2352 x 1568 pixels · 45° FOV · color fundus photograph: 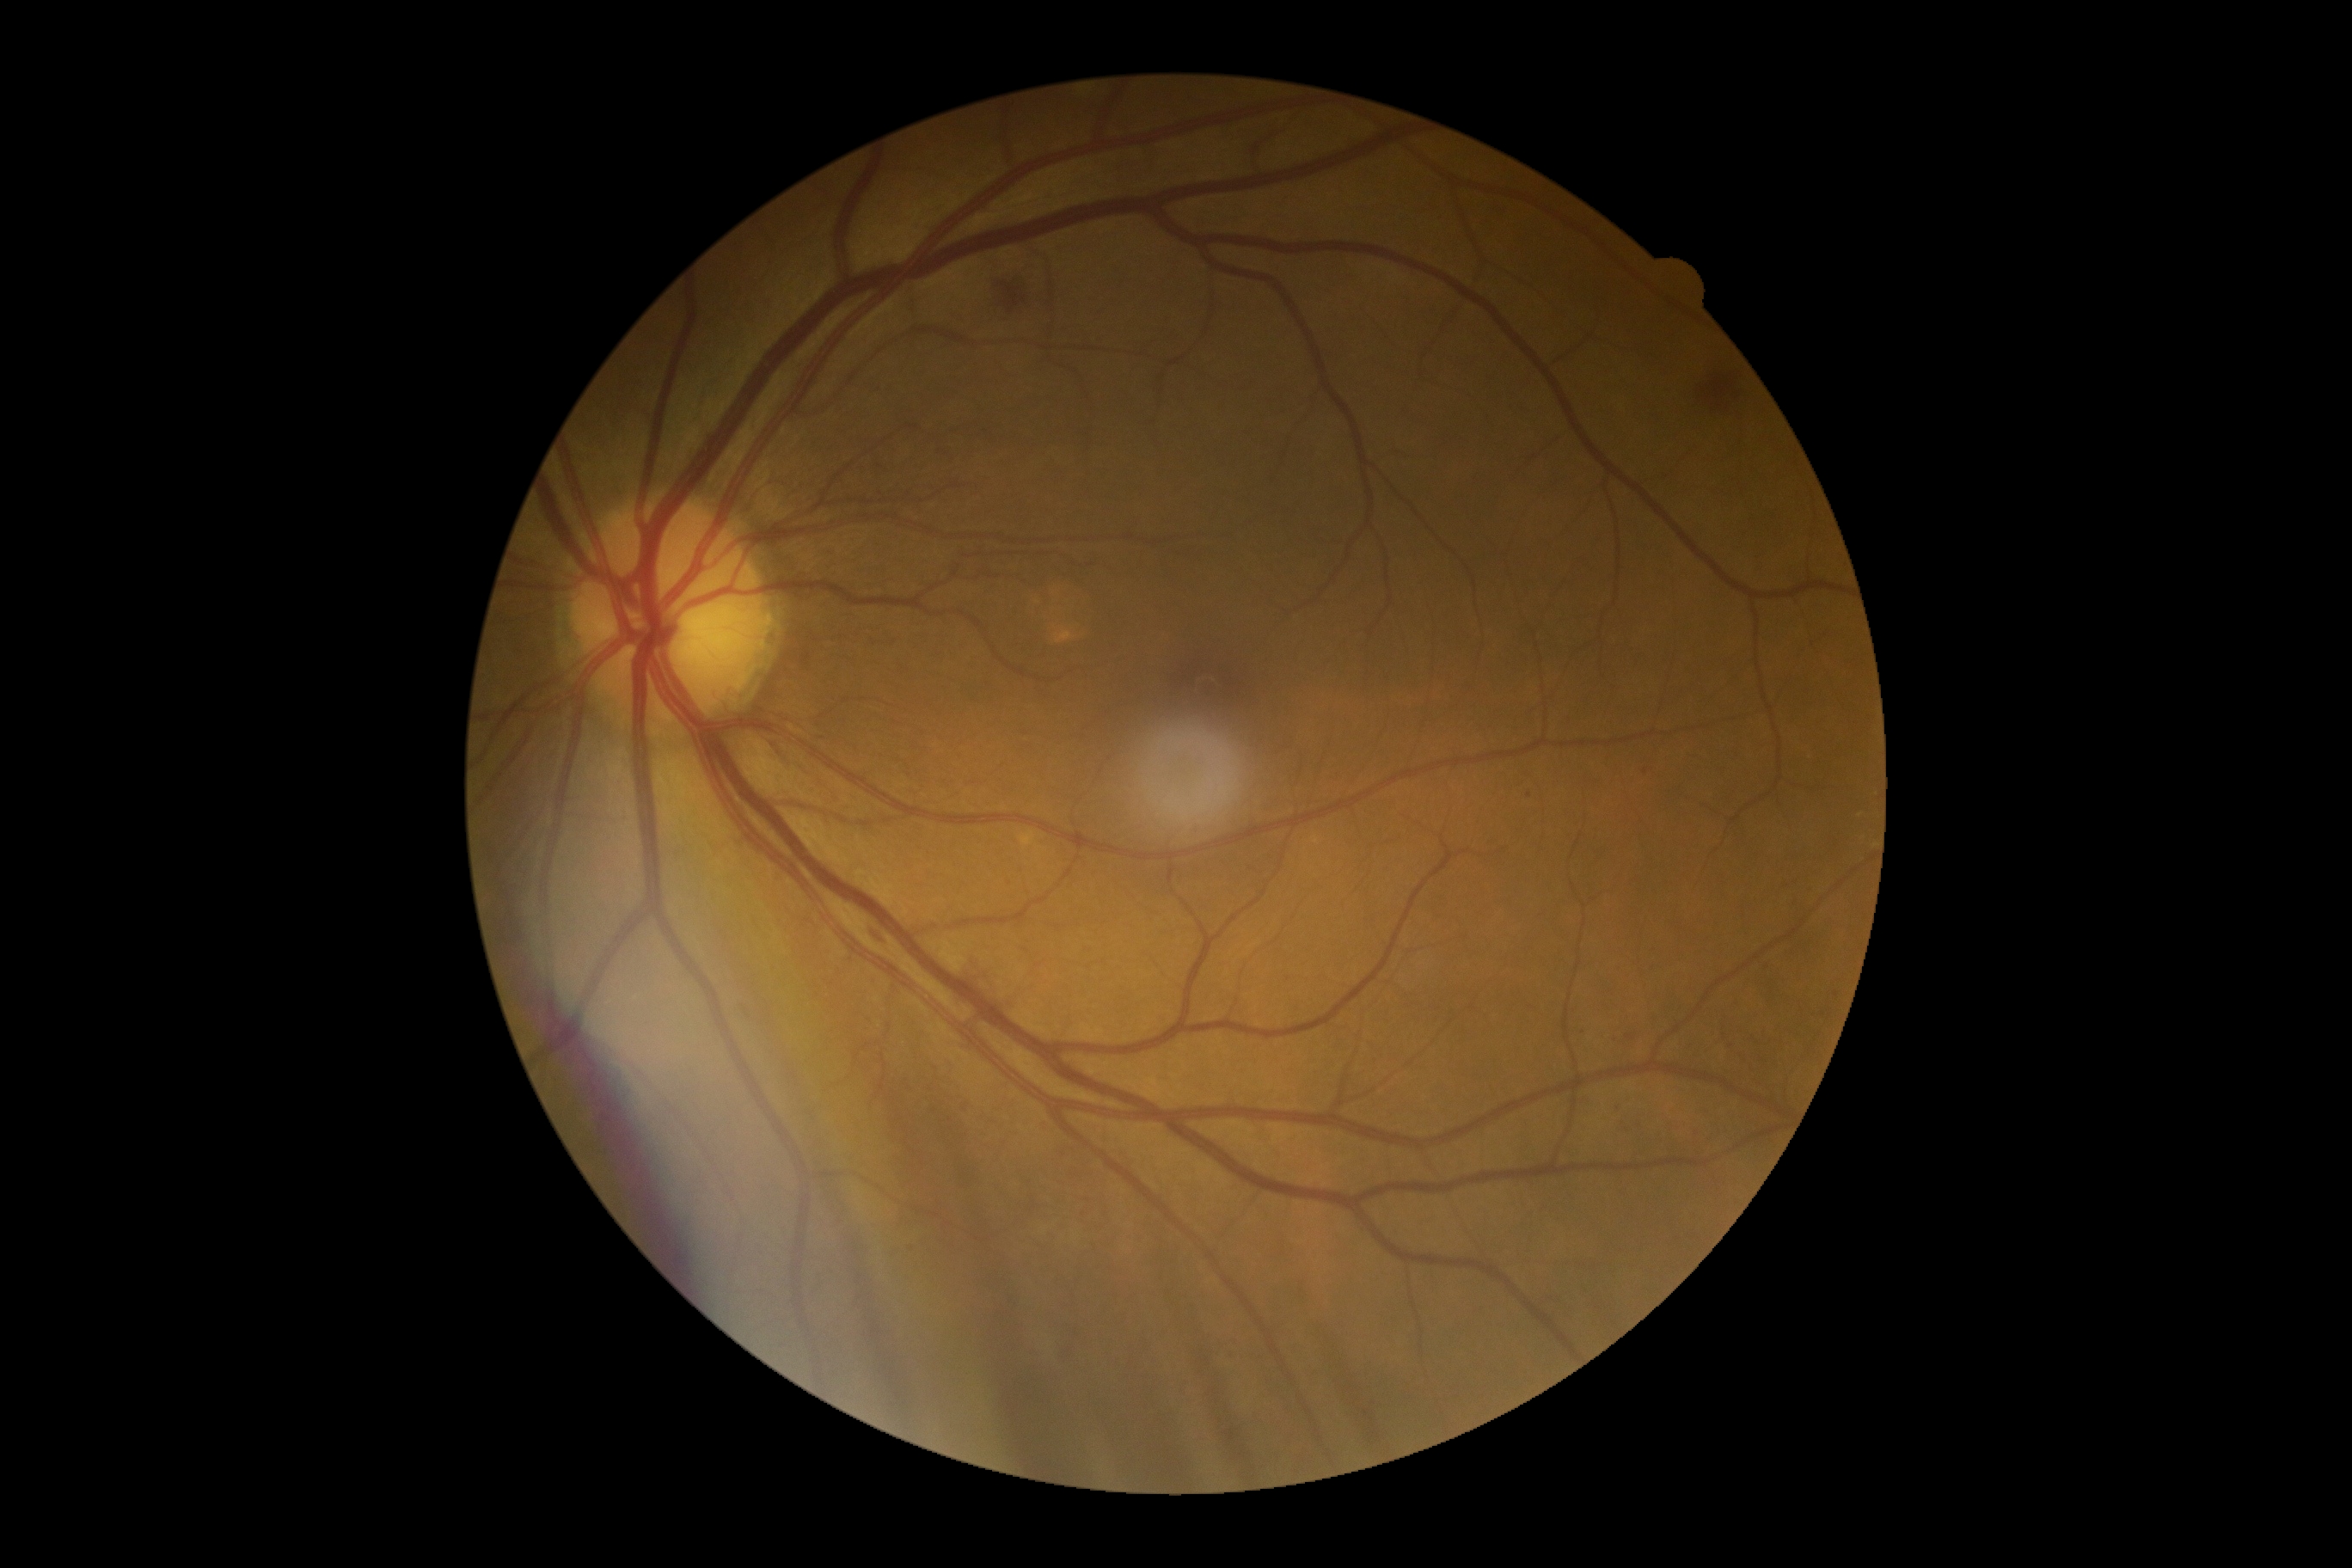   dr_grade: 3 — more than 20 intraretinal hemorrhages in each of 4 quadrants, definite venous beading in 2 or more quadrants, or prominent intraretinal microvascular abnormalities in 1 or more quadrants, with no signs of proliferative retinopathy